Pupil-dilated: 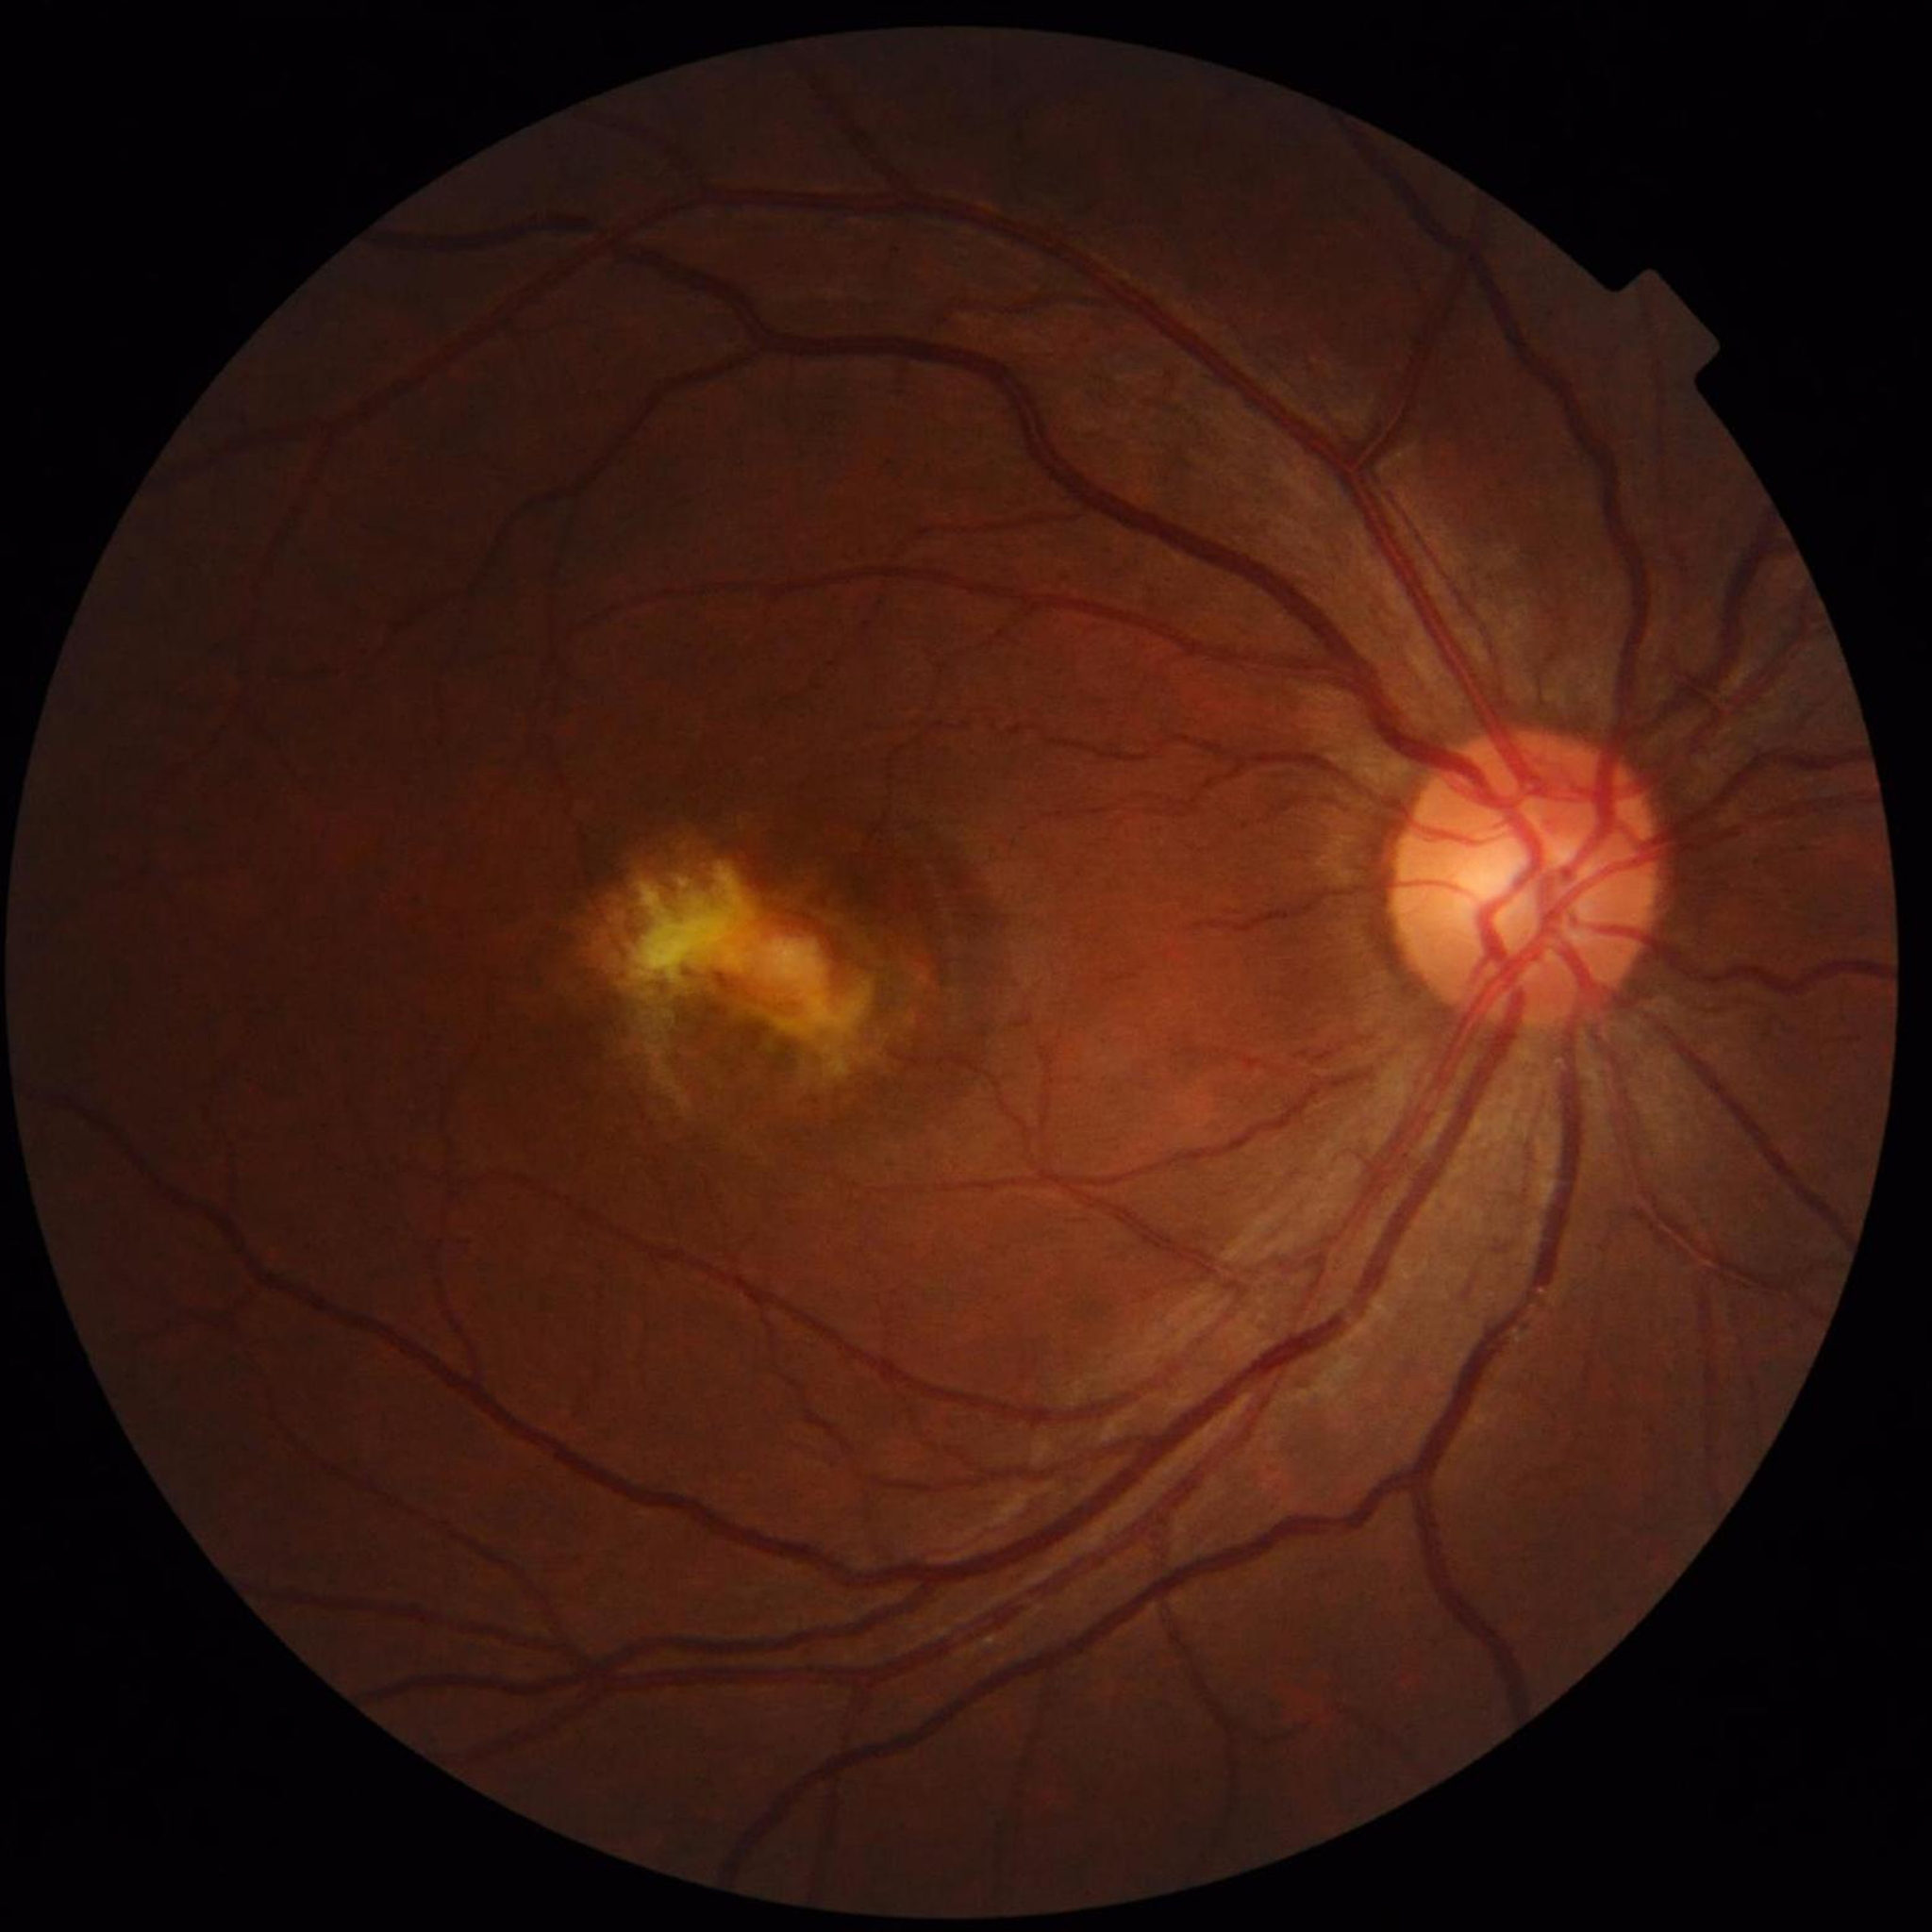 Automated quality assessment: good. Eye affected by age-related macular degeneration.